IOP: 17 mmHg · axial length 23.84 mm · central corneal thickness 508 µm · woman patient — 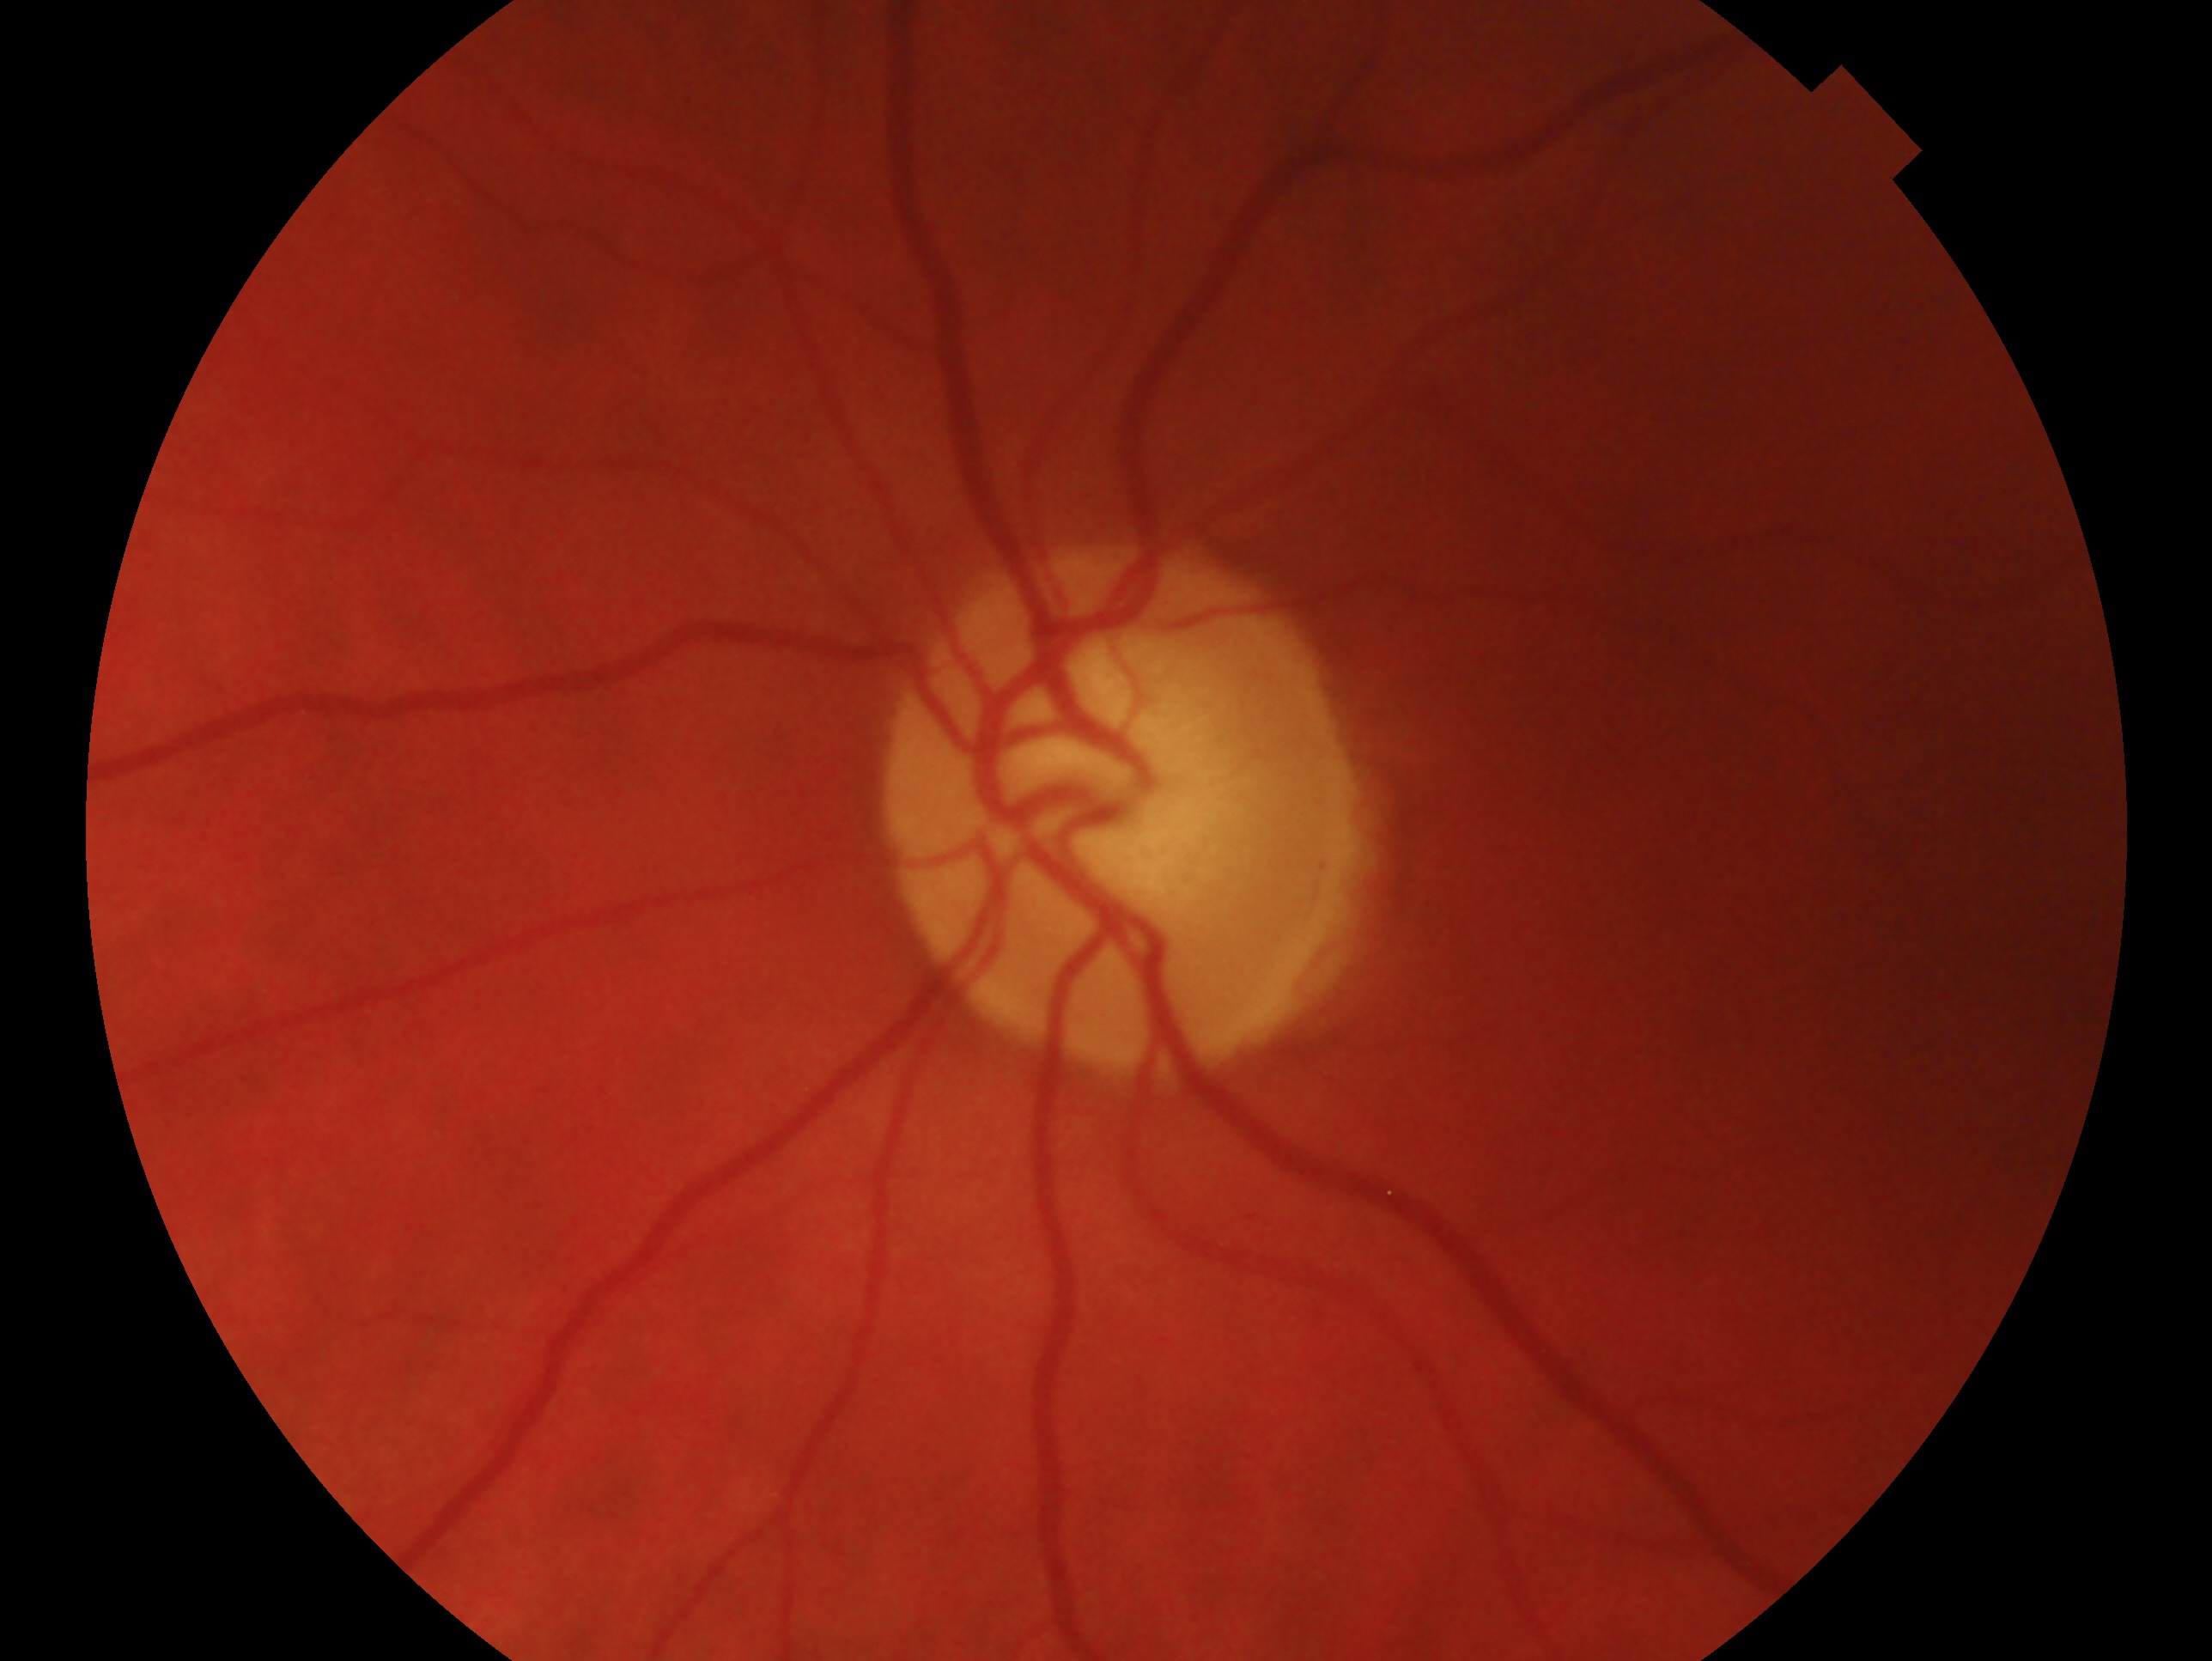 Clinical classification — possible glaucoma.
This is the OS.